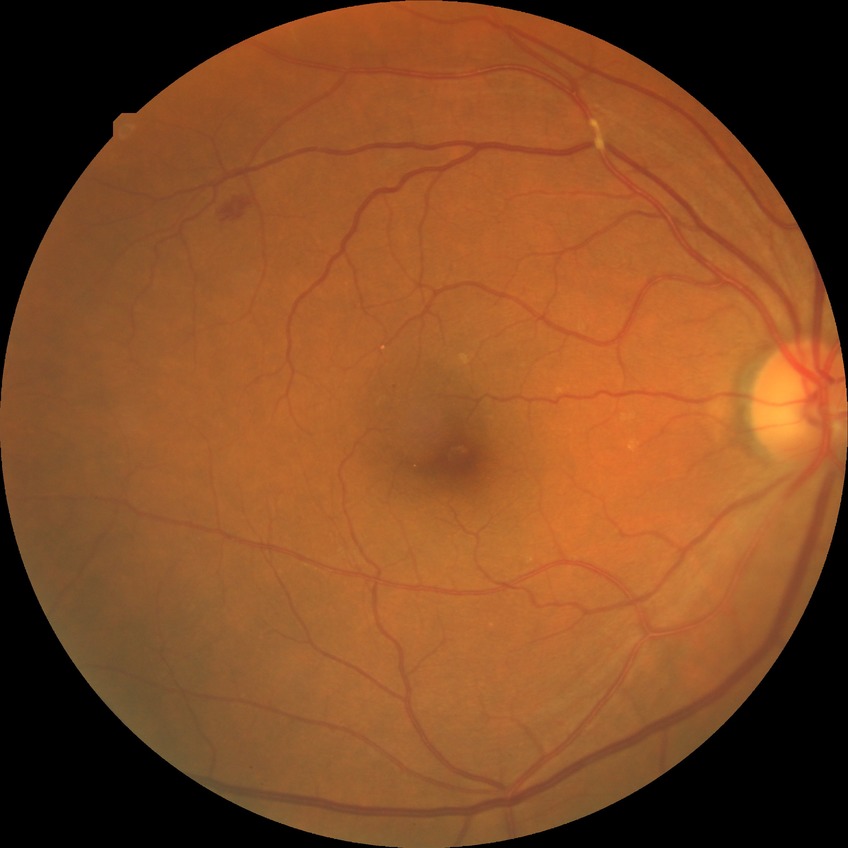

  davis_grade: SDR (simple diabetic retinopathy)